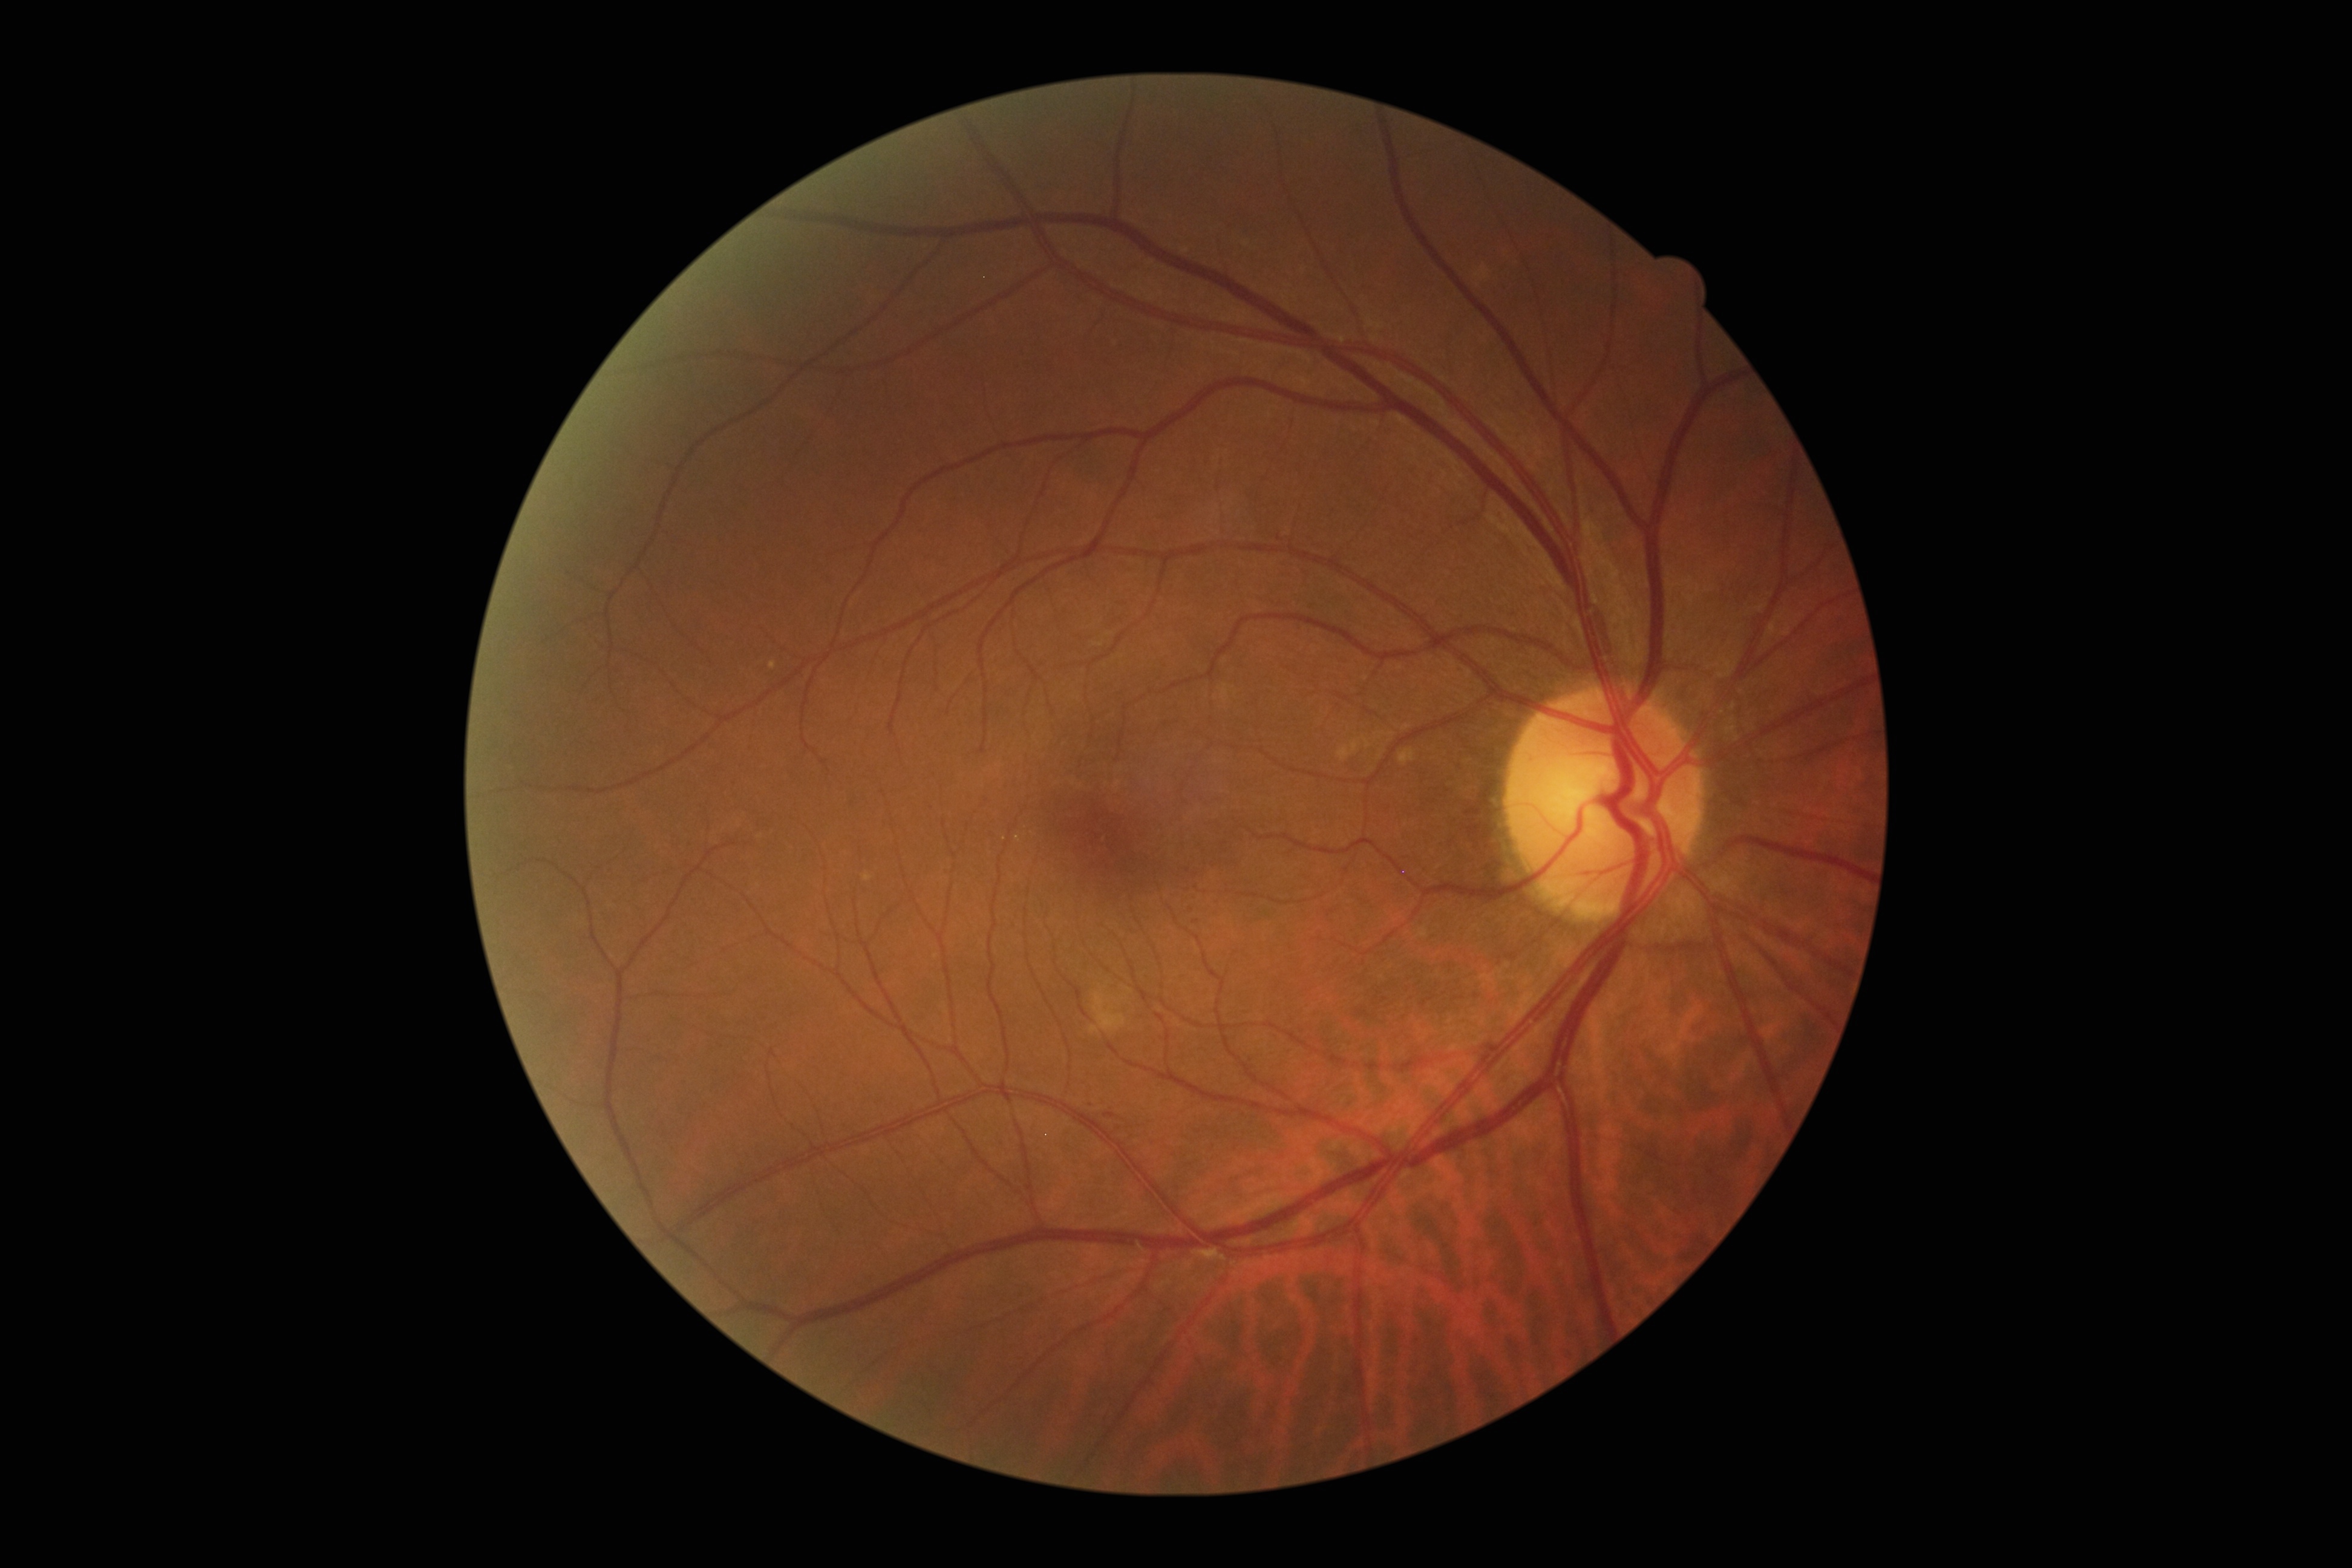
{
  "dr_category": "non-proliferative diabetic retinopathy",
  "dr_grade": "1 (mild NPDR)"
}